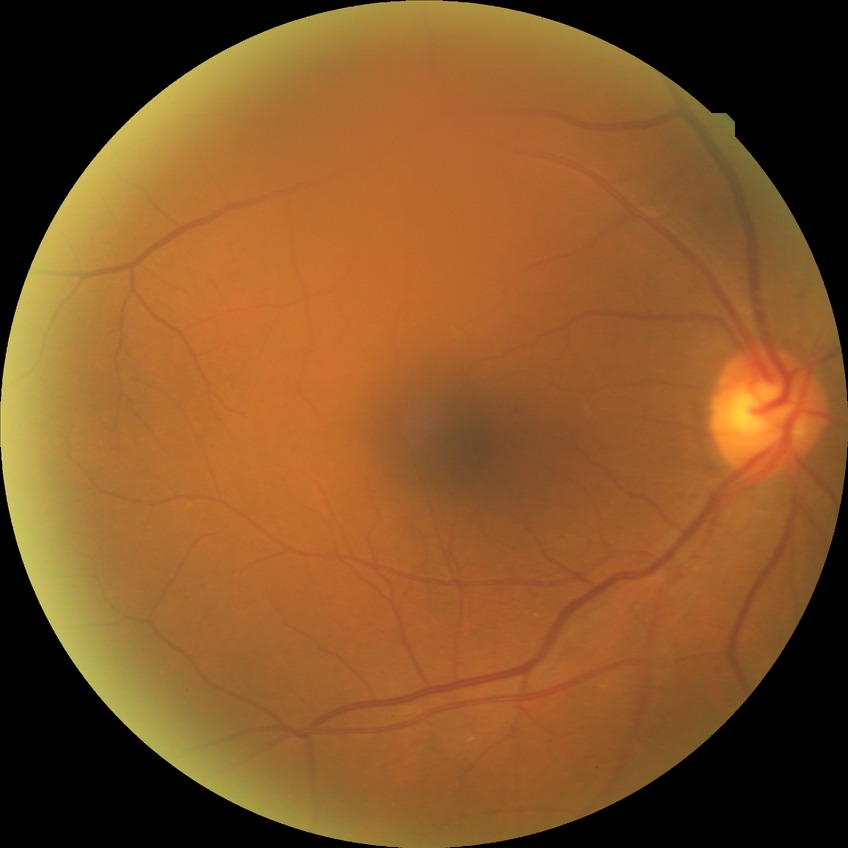

Diabetic retinopathy (DR) is NDR (no diabetic retinopathy).